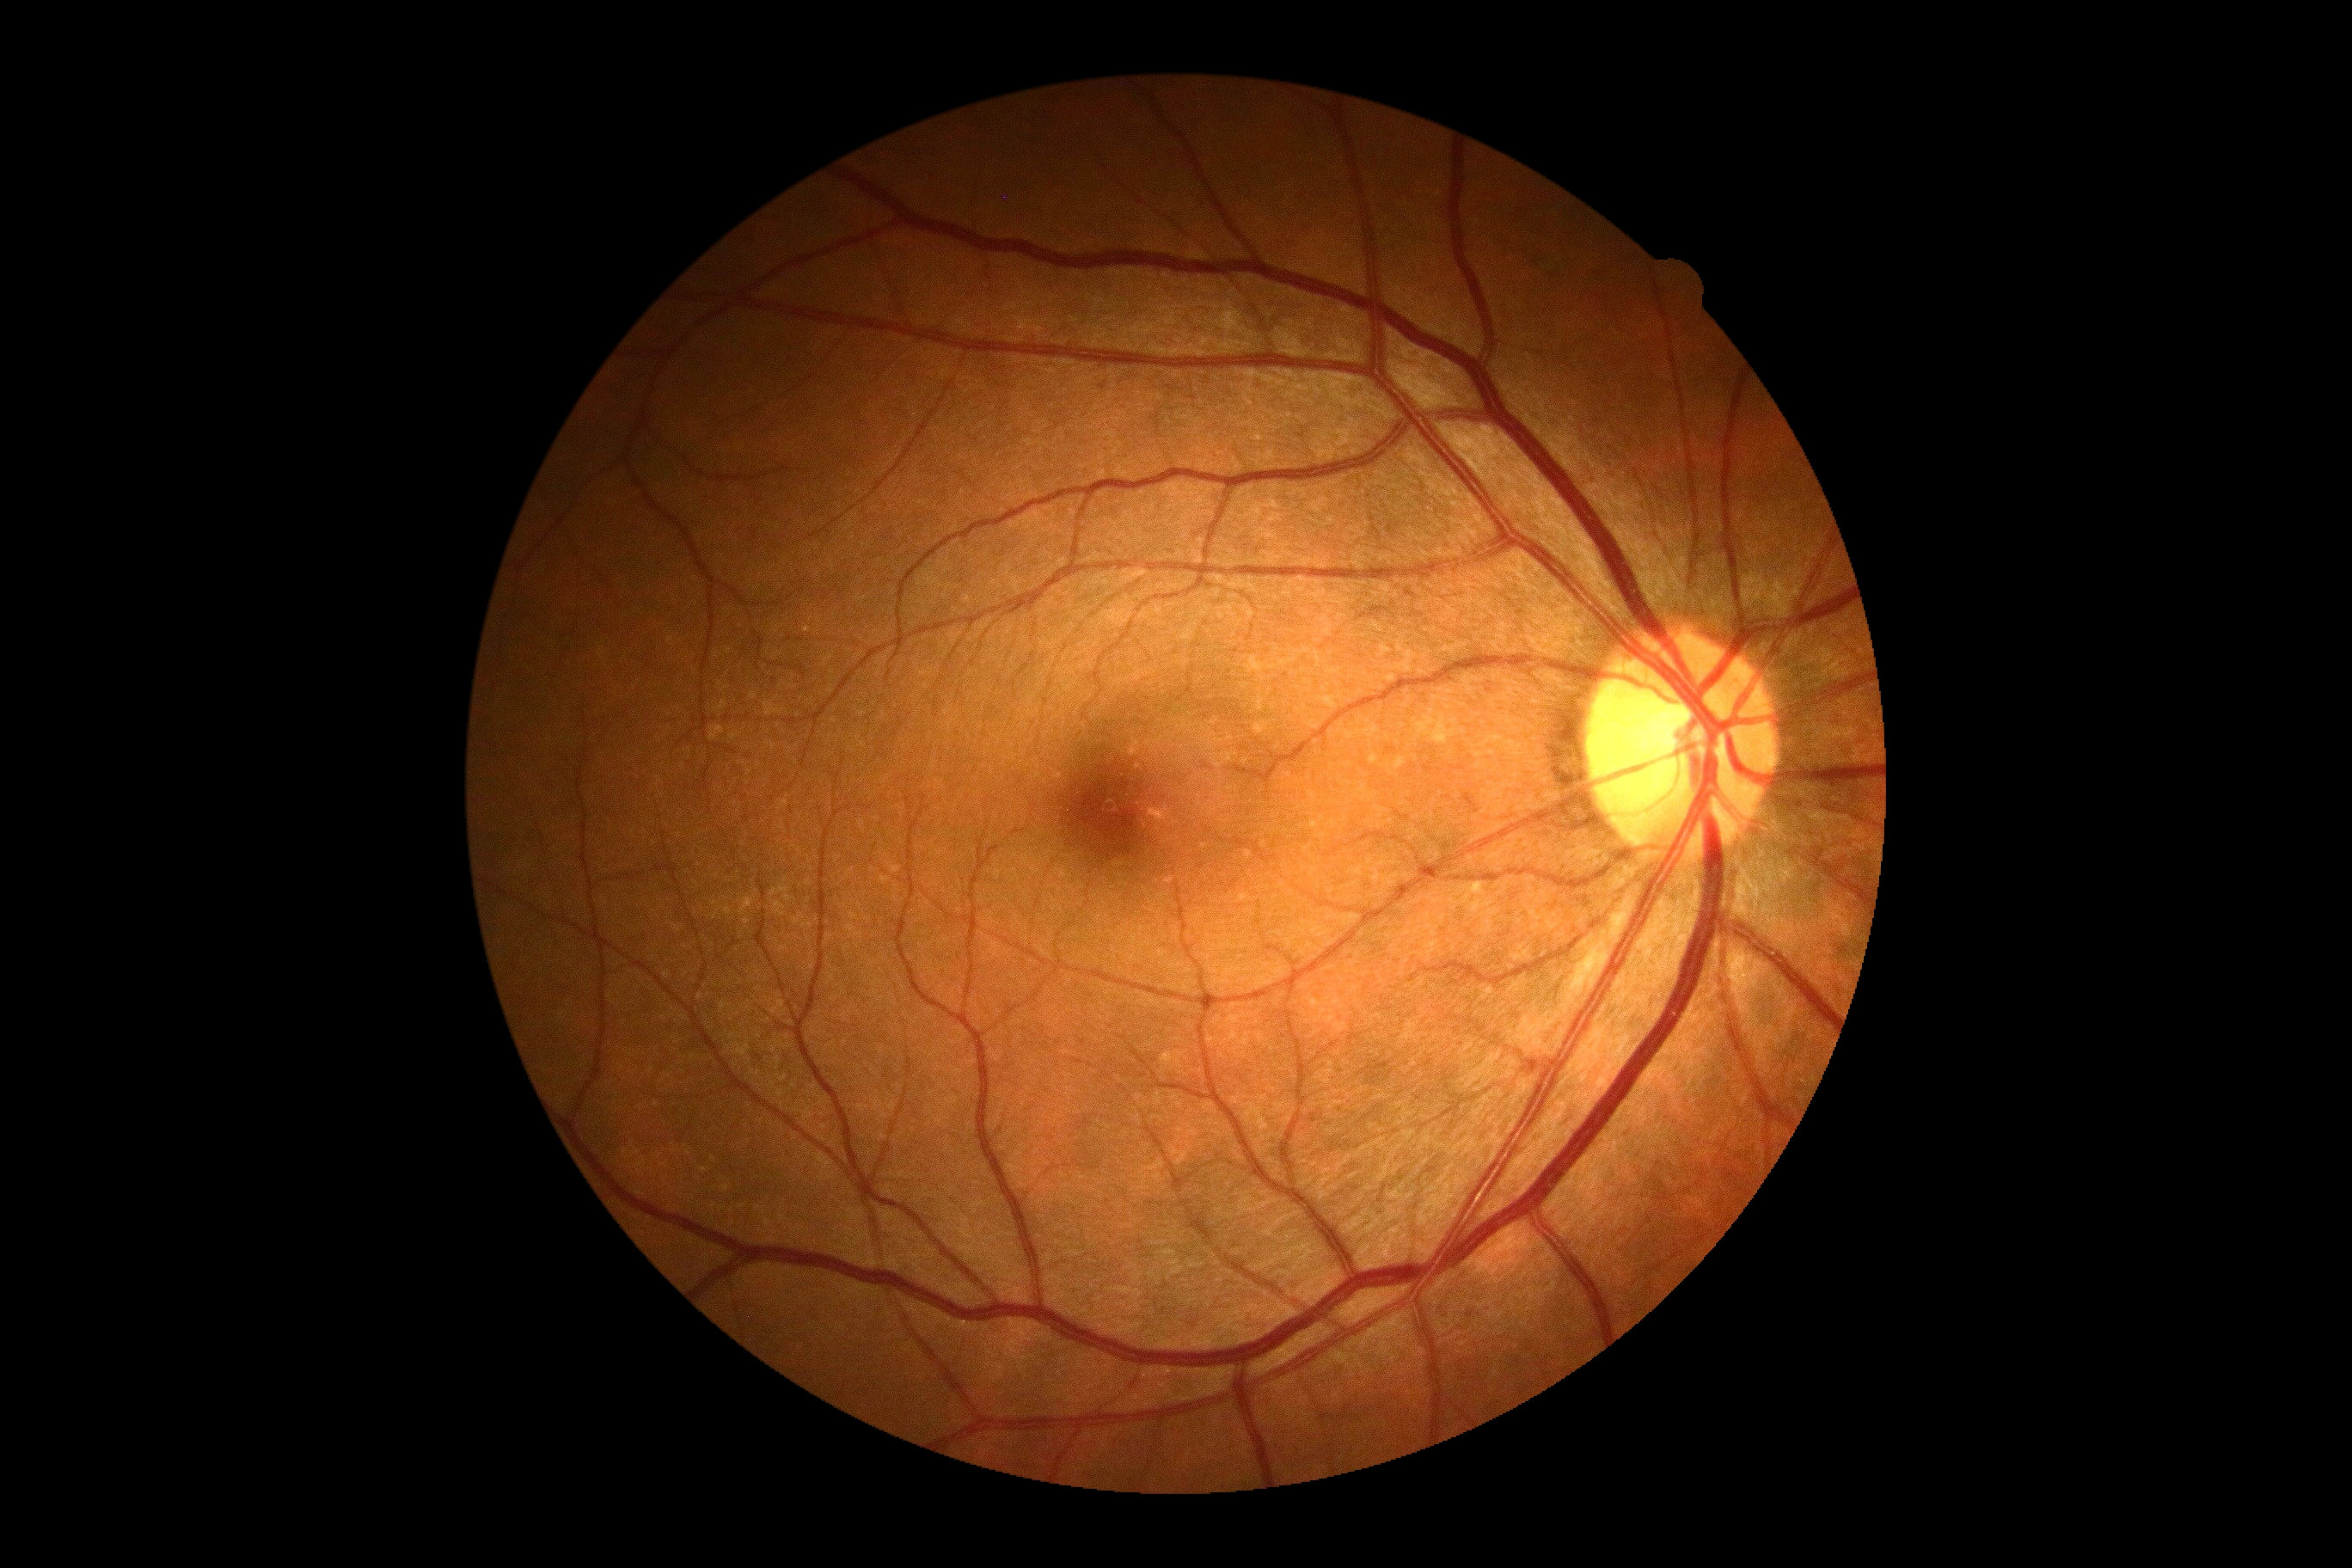 No DR findings. DR severity: grade 0.